45° FOV; color fundus image — 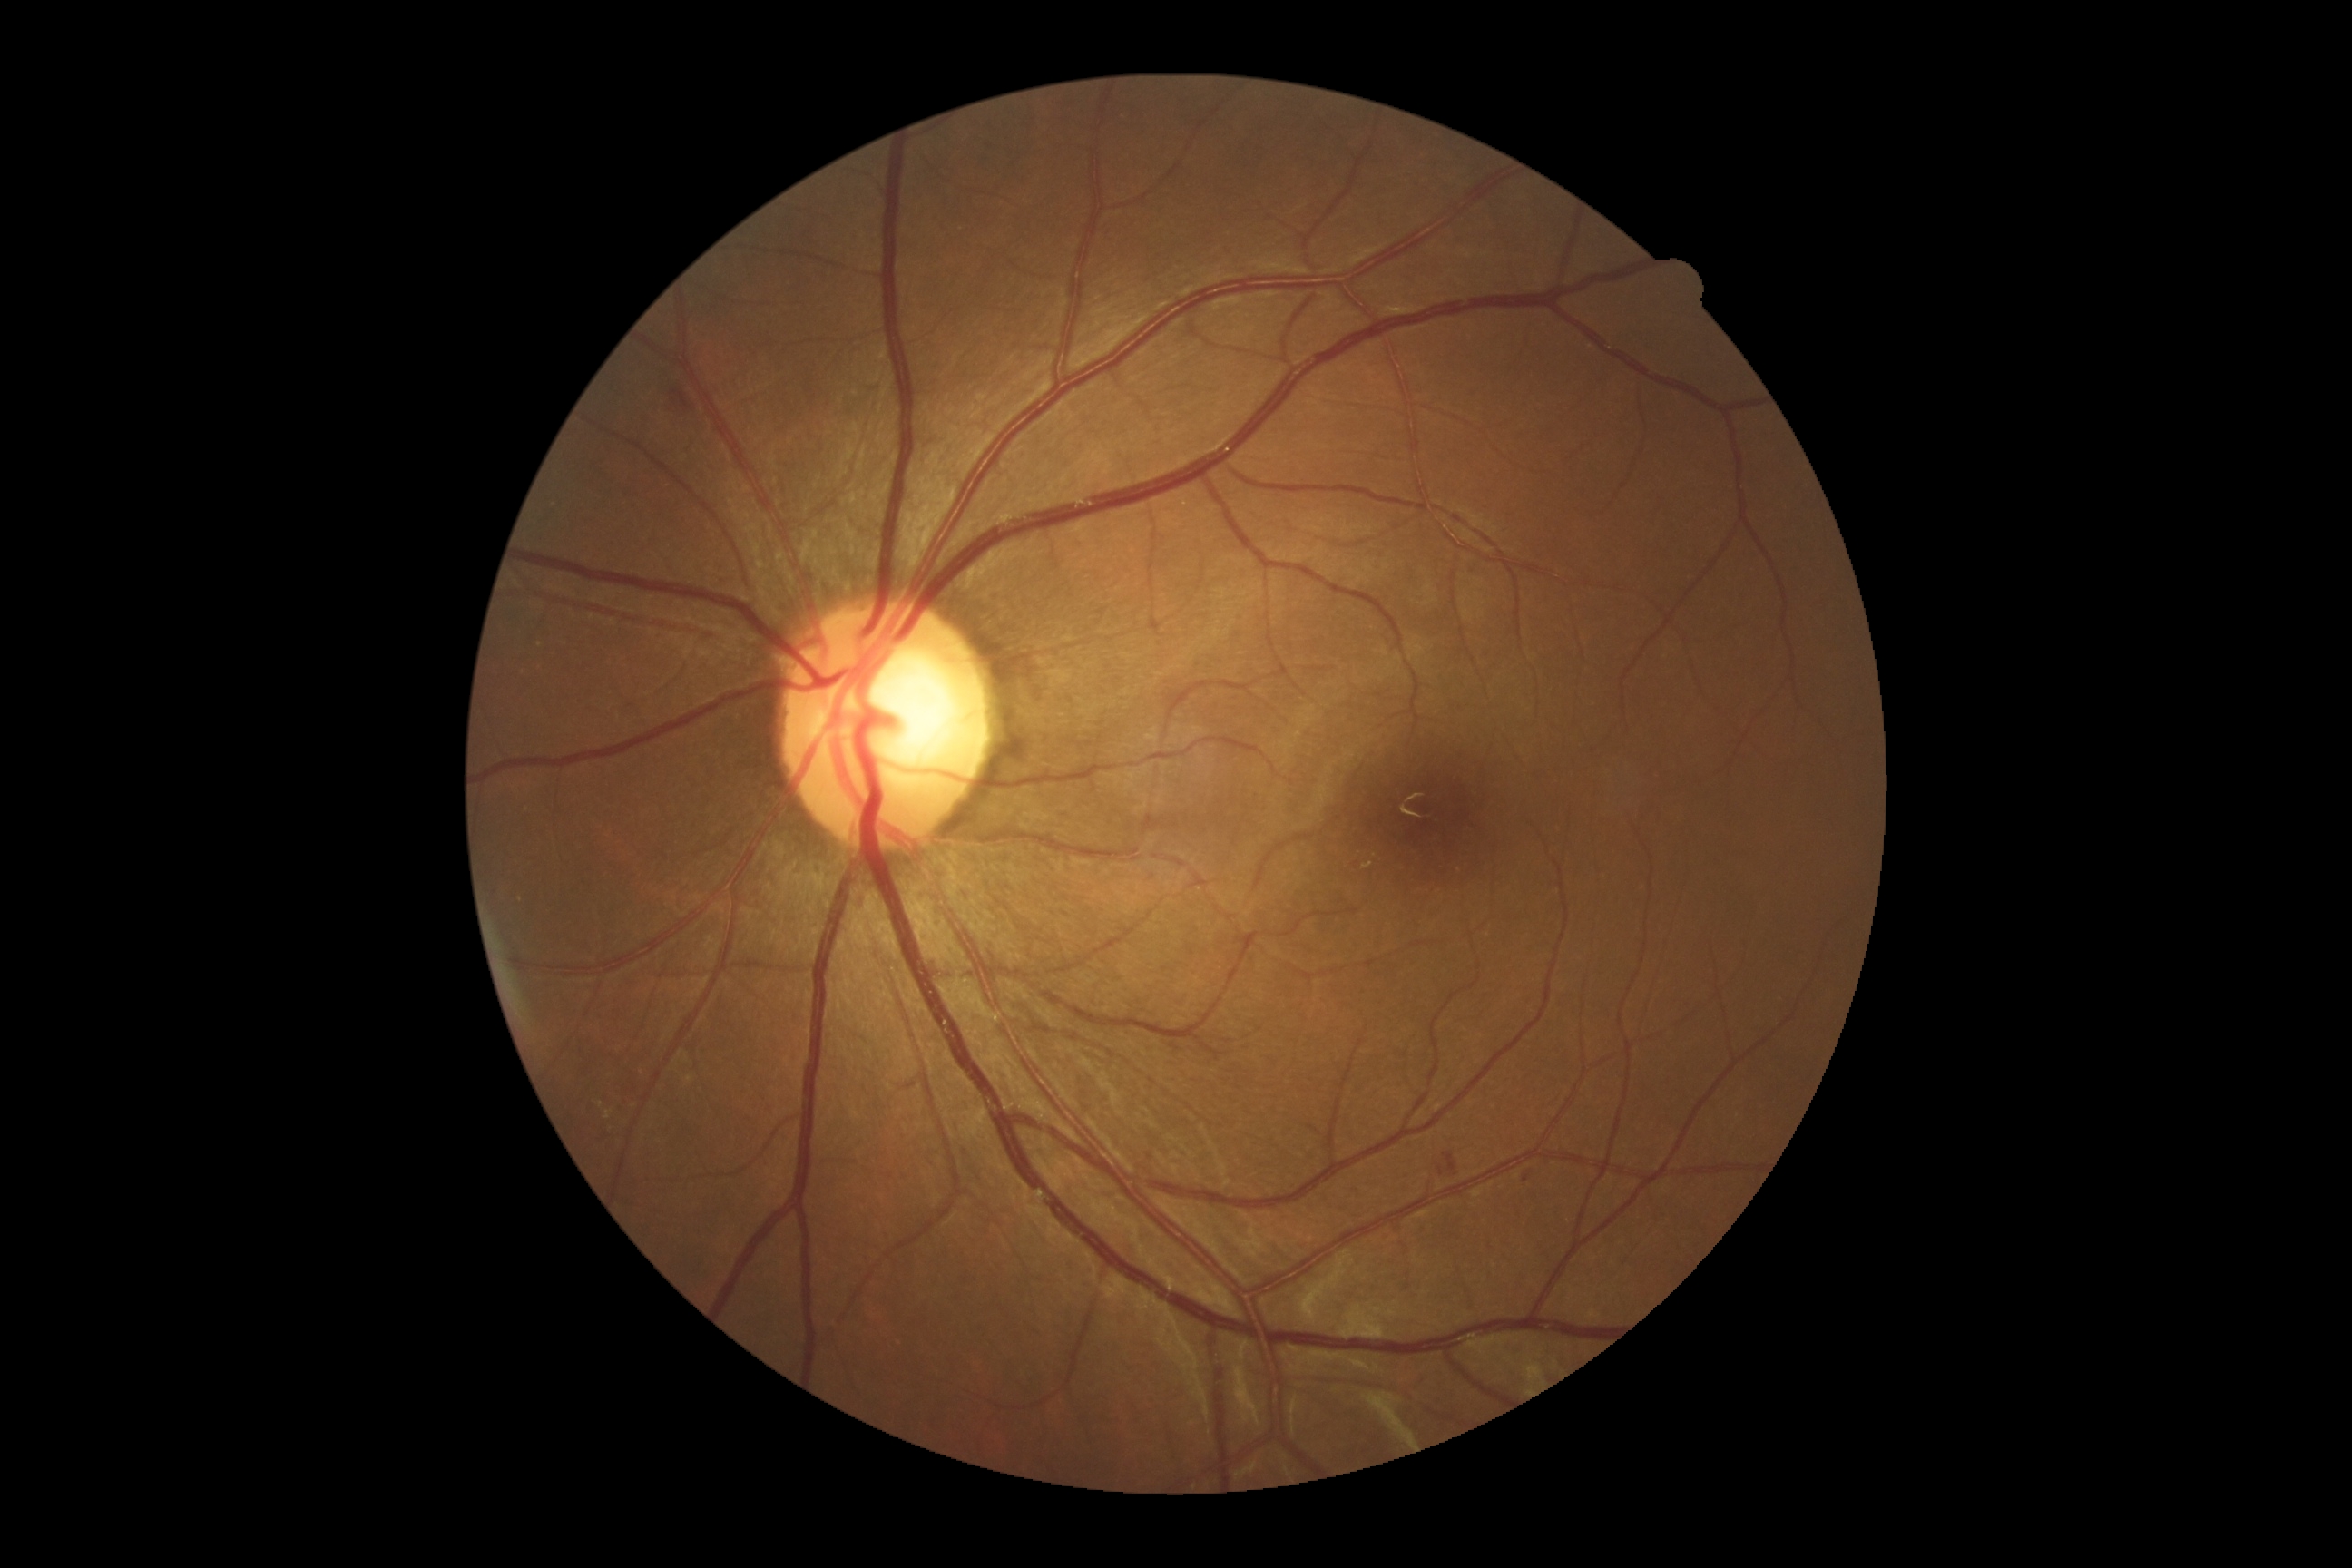
DR class = non-proliferative diabetic retinopathy
diabetic retinopathy = moderate NPDR (grade 2) — more than just microaneurysms but less than severe NPDR